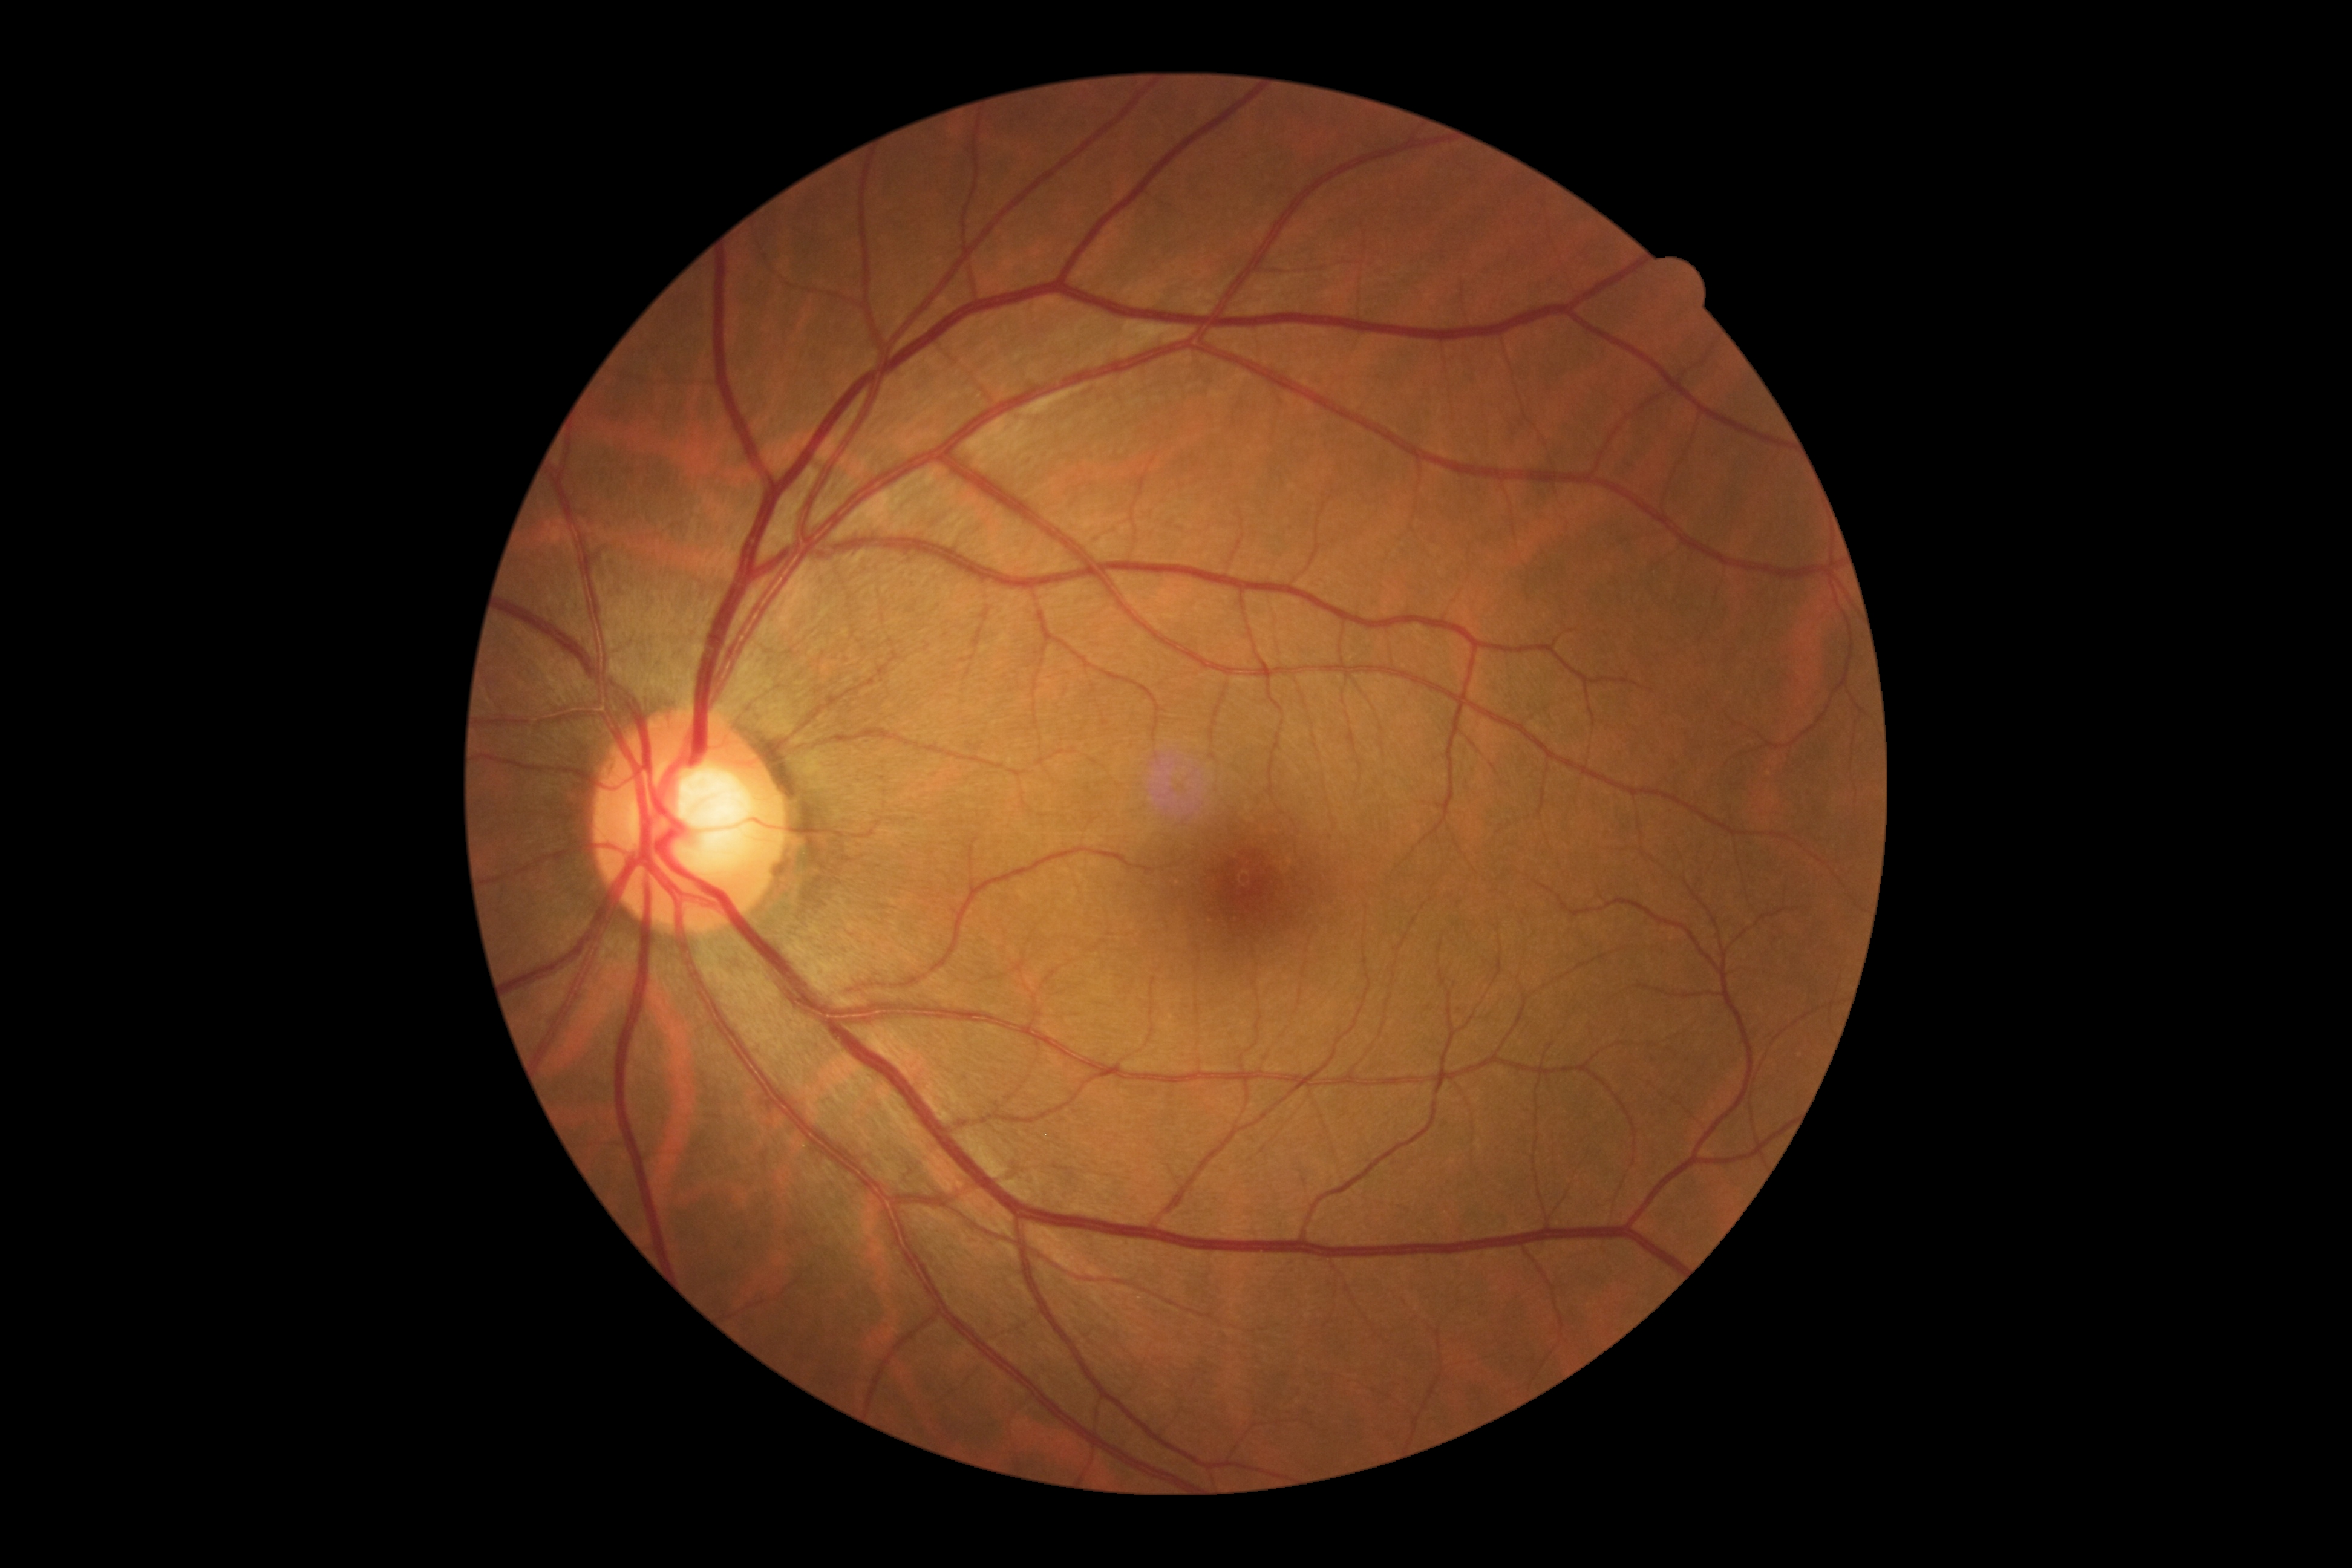 No DR findings.
Diabetic retinopathy (DR): no apparent retinopathy (grade 0).